No pharmacologic dilation · 45° field of view · modified Davis grading · NIDEK AFC-230 · 848x848px: 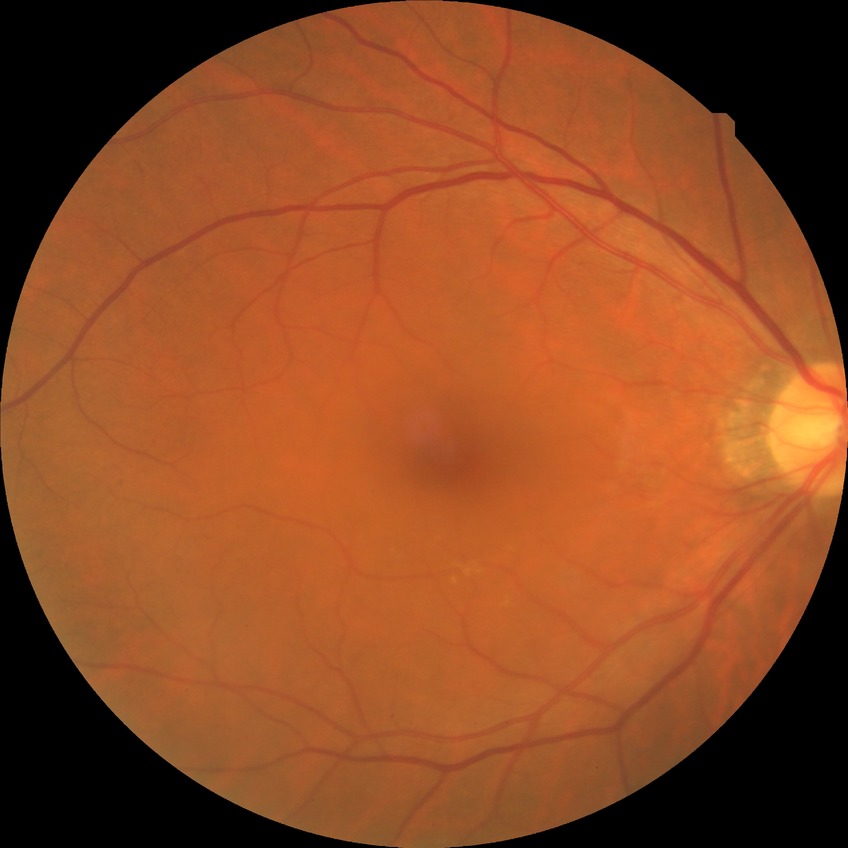
diabetic retinopathy stage = no diabetic retinopathy.